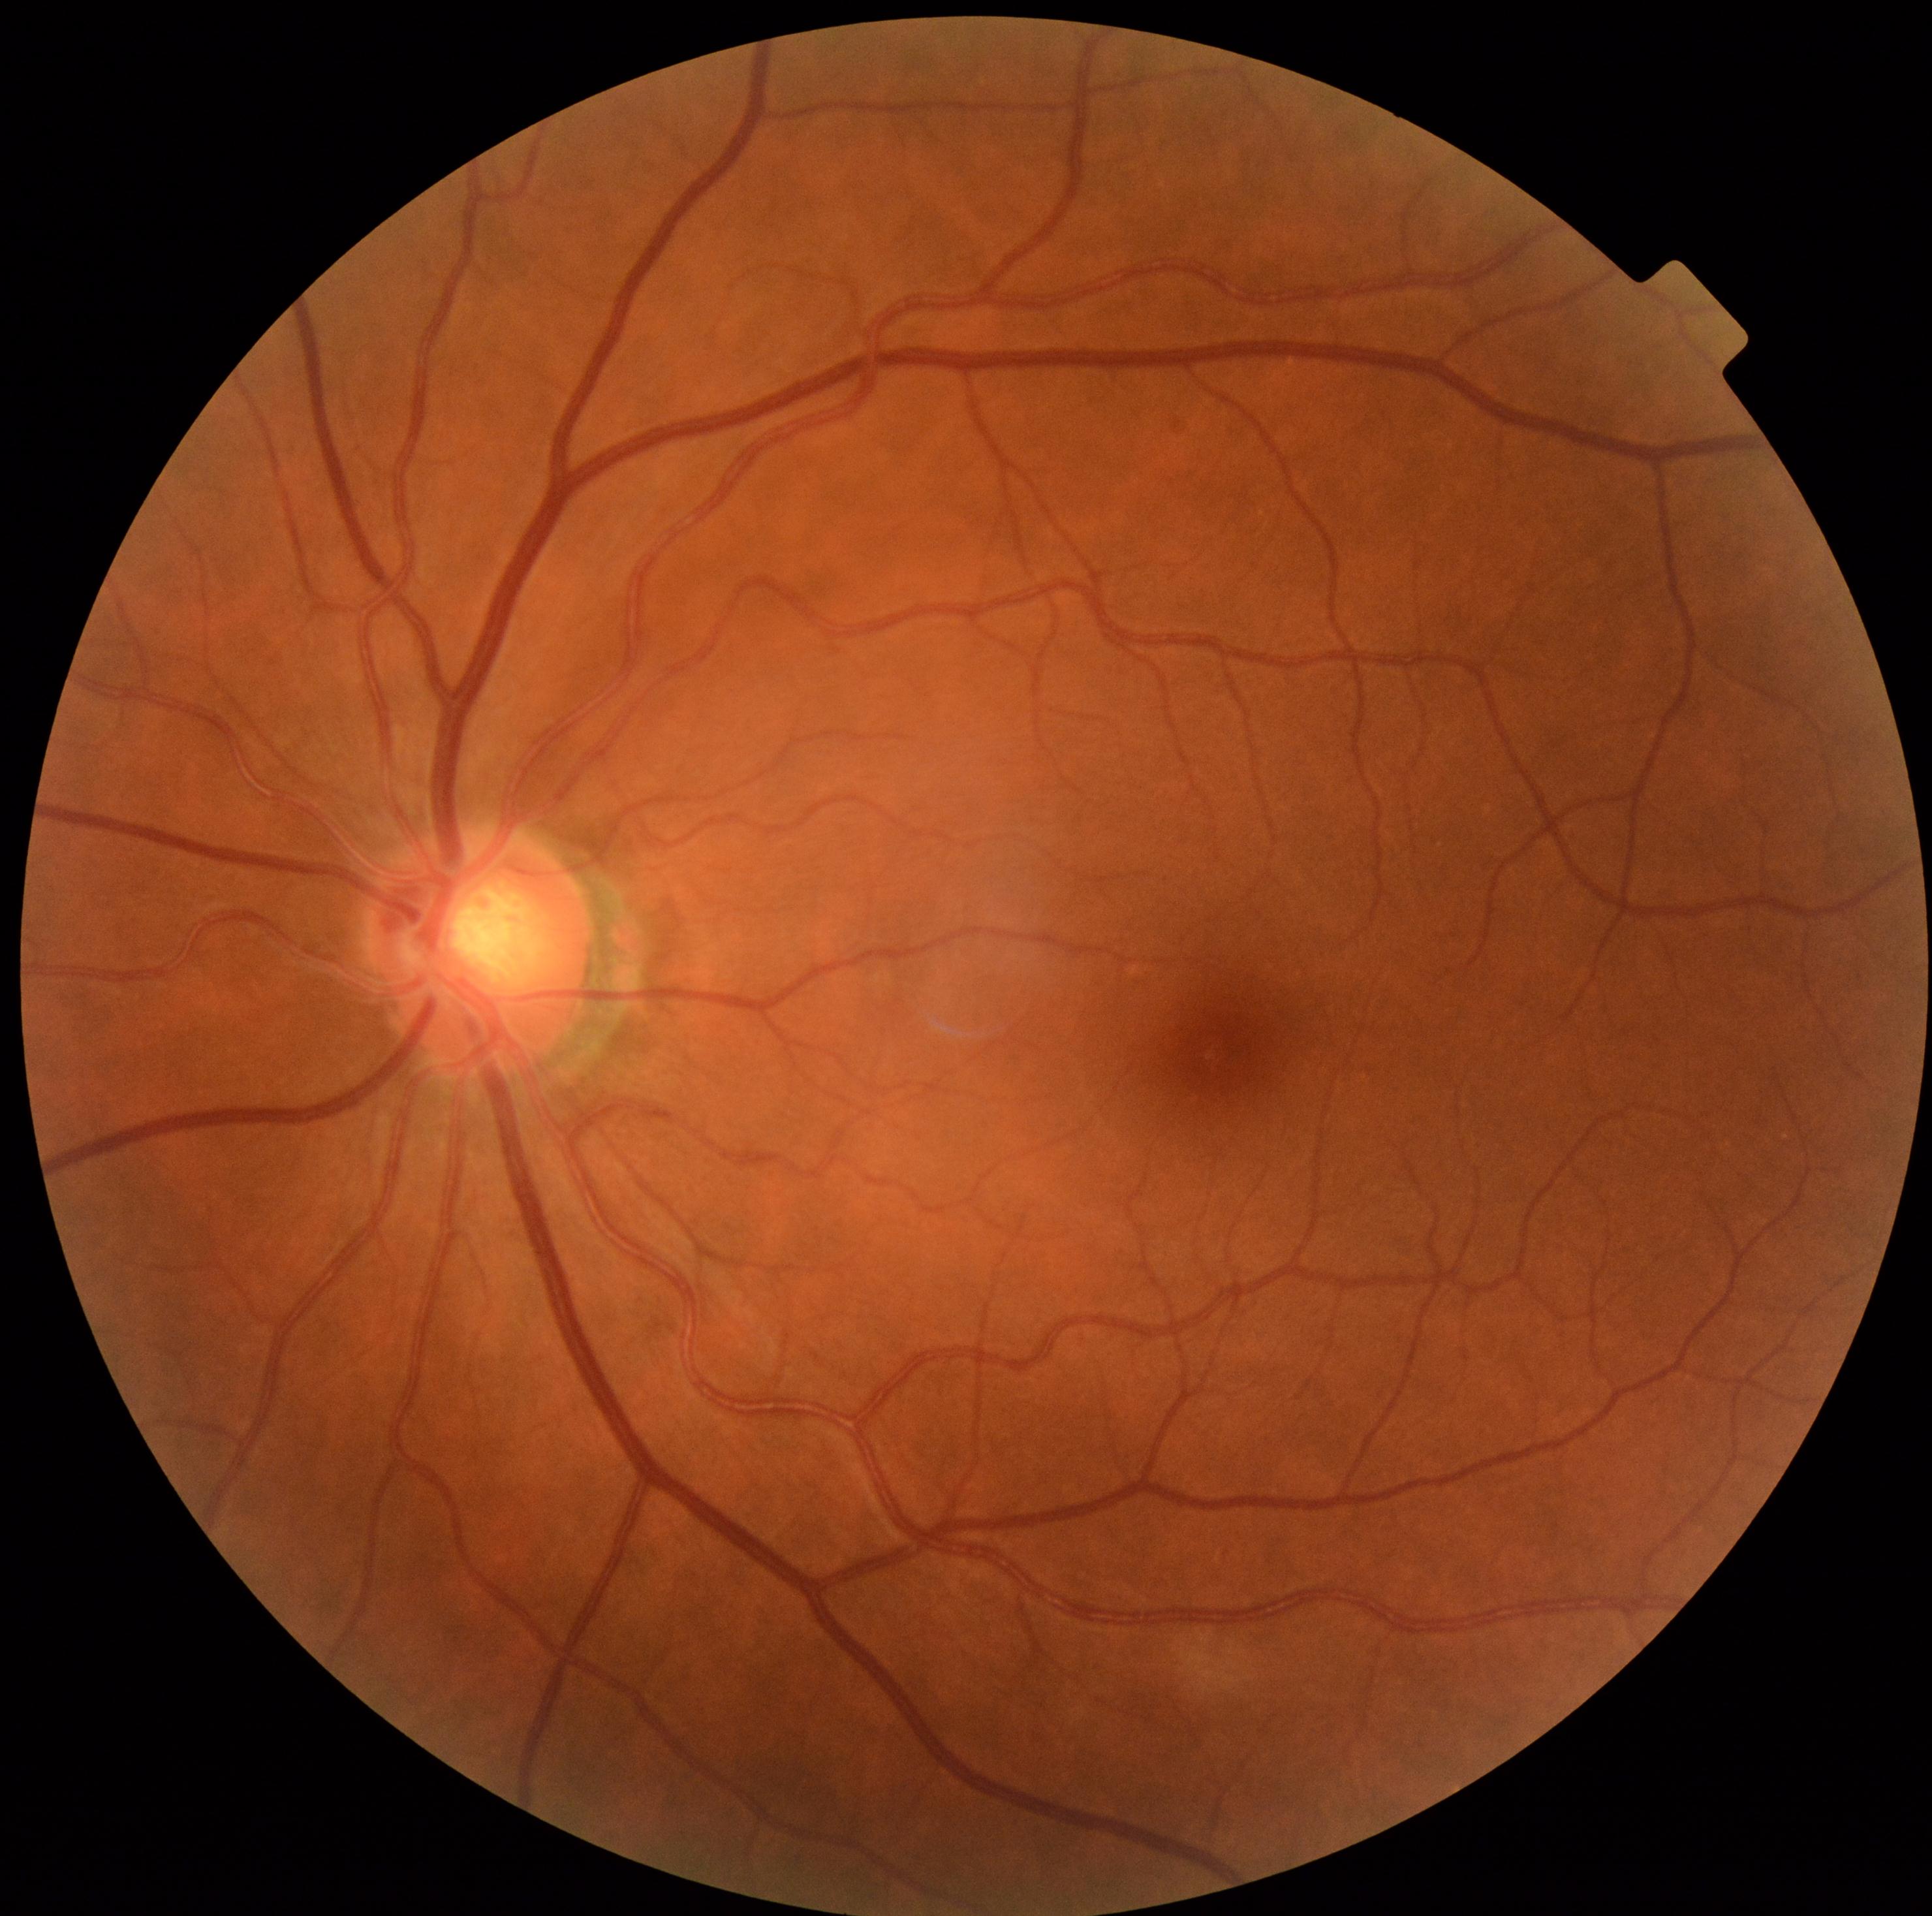

DR is no apparent diabetic retinopathy (grade 0).